Remidio Fundus on Phone. Color fundus photograph.
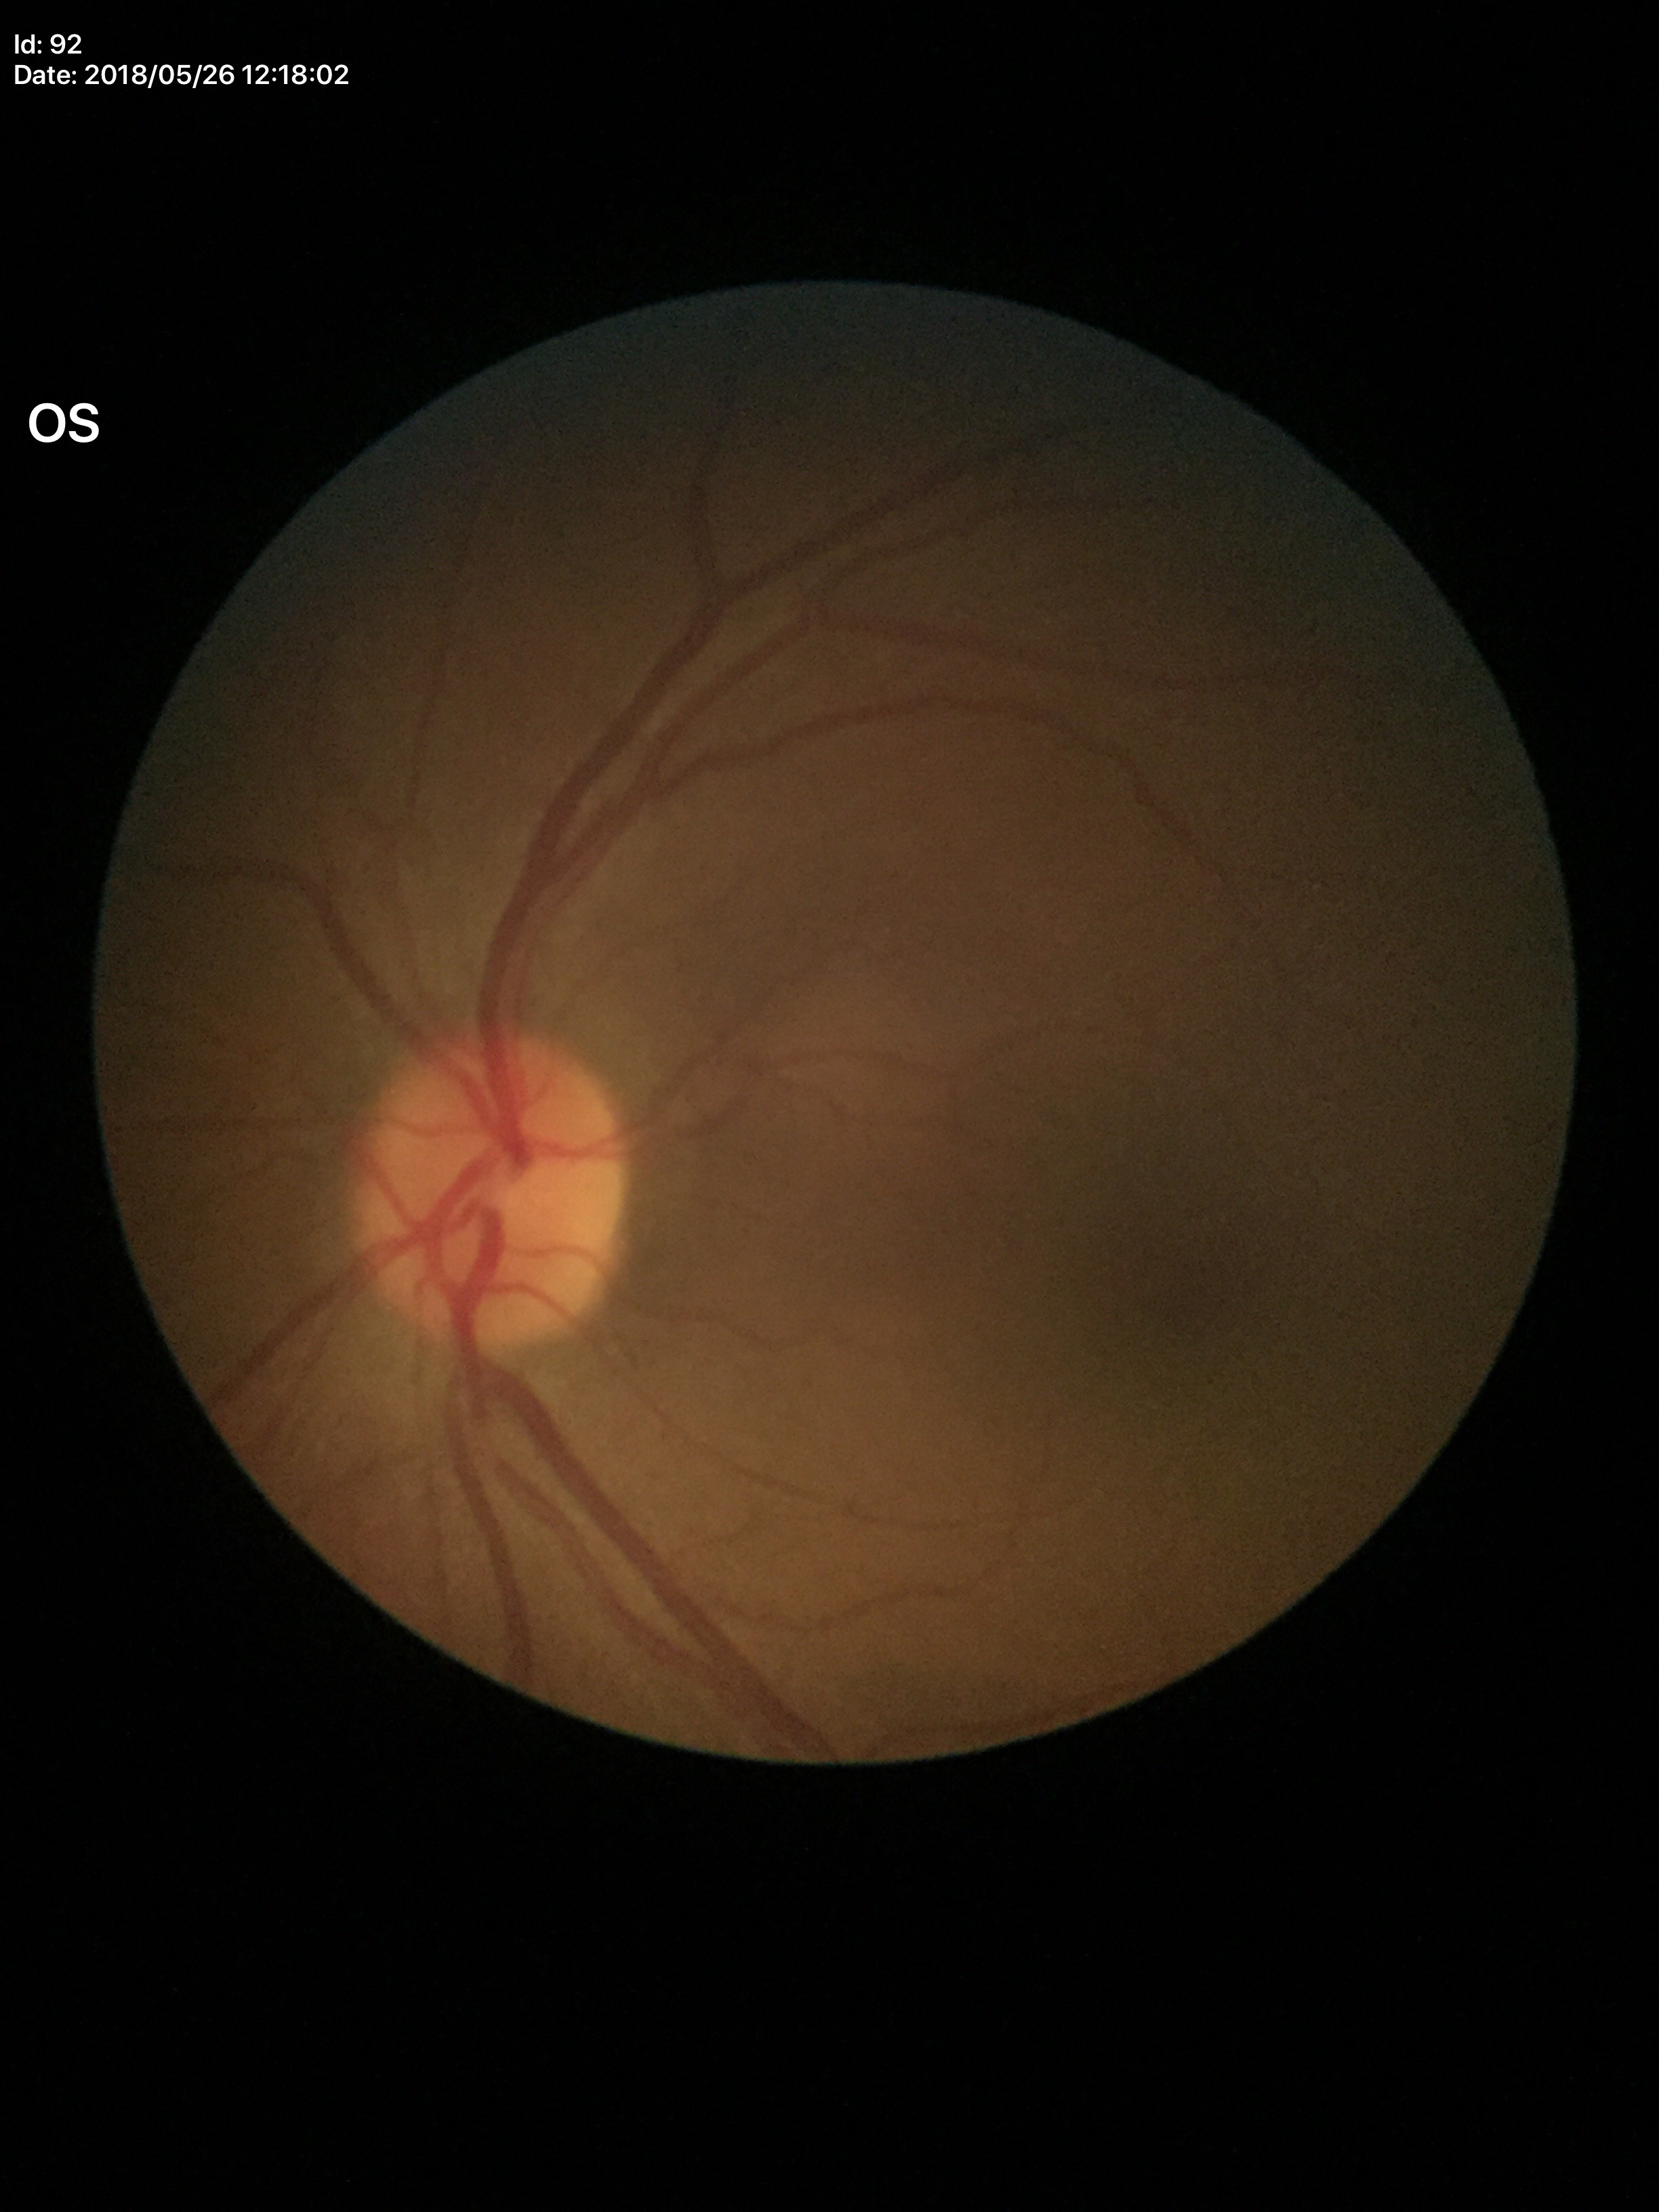 Vertical C/D ratio of 0.49.
No glaucomatous findings.
Area cup-disc ratio is 0.23.